240 by 240 pixels.
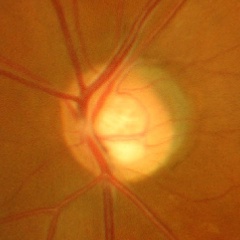

Optic disc photograph demonstrating severe glaucomatous damage.